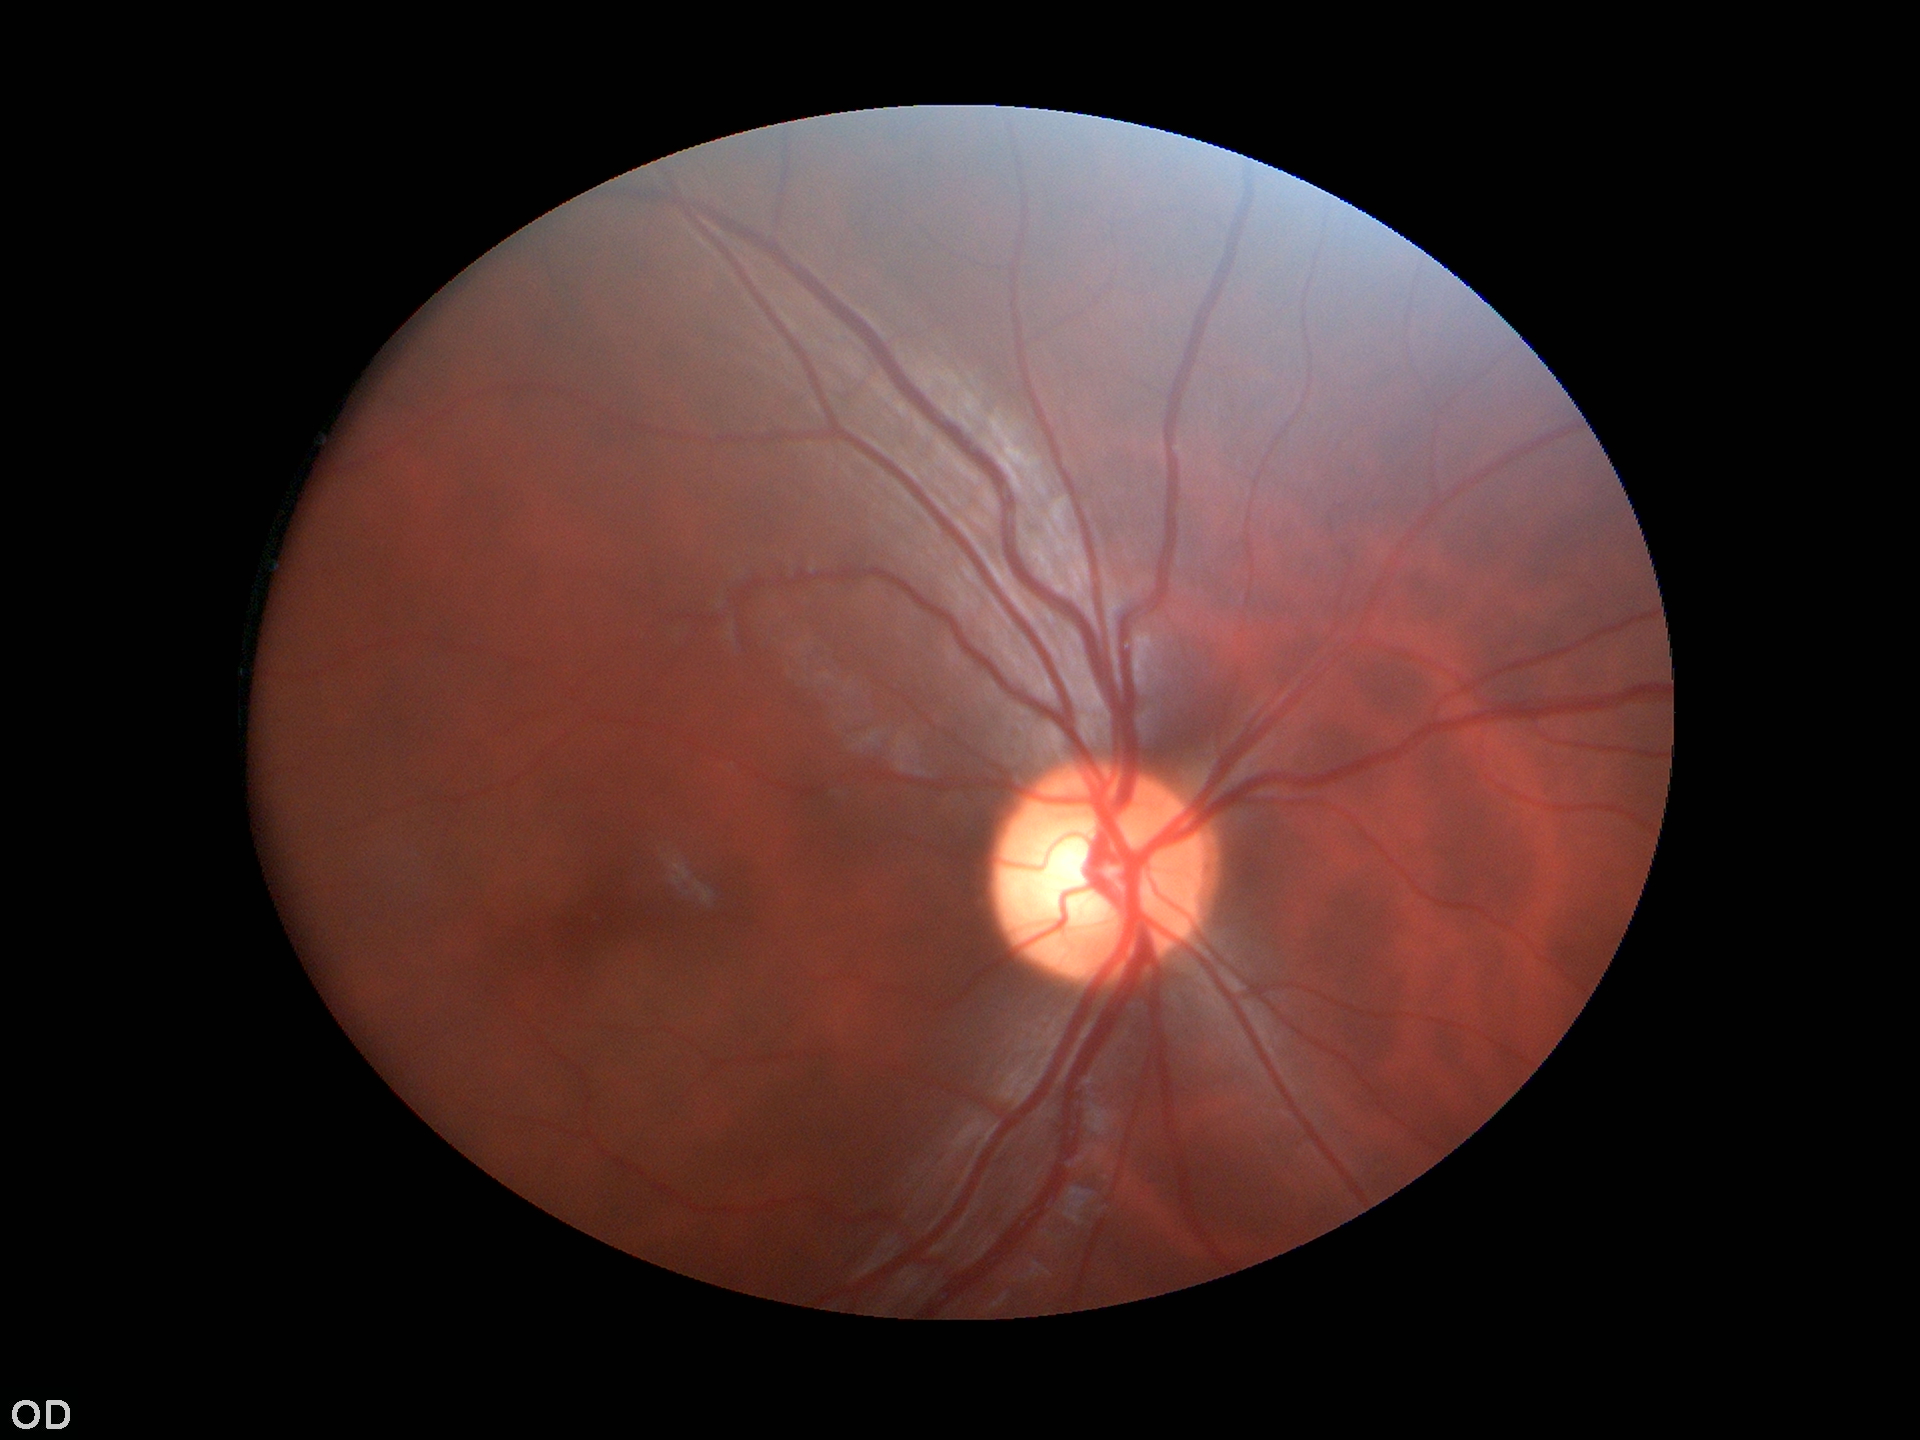

Not suspicious for glaucoma.
Vertical cup-to-disc ratio: 0.57.